45° FOV, retinal fundus photograph
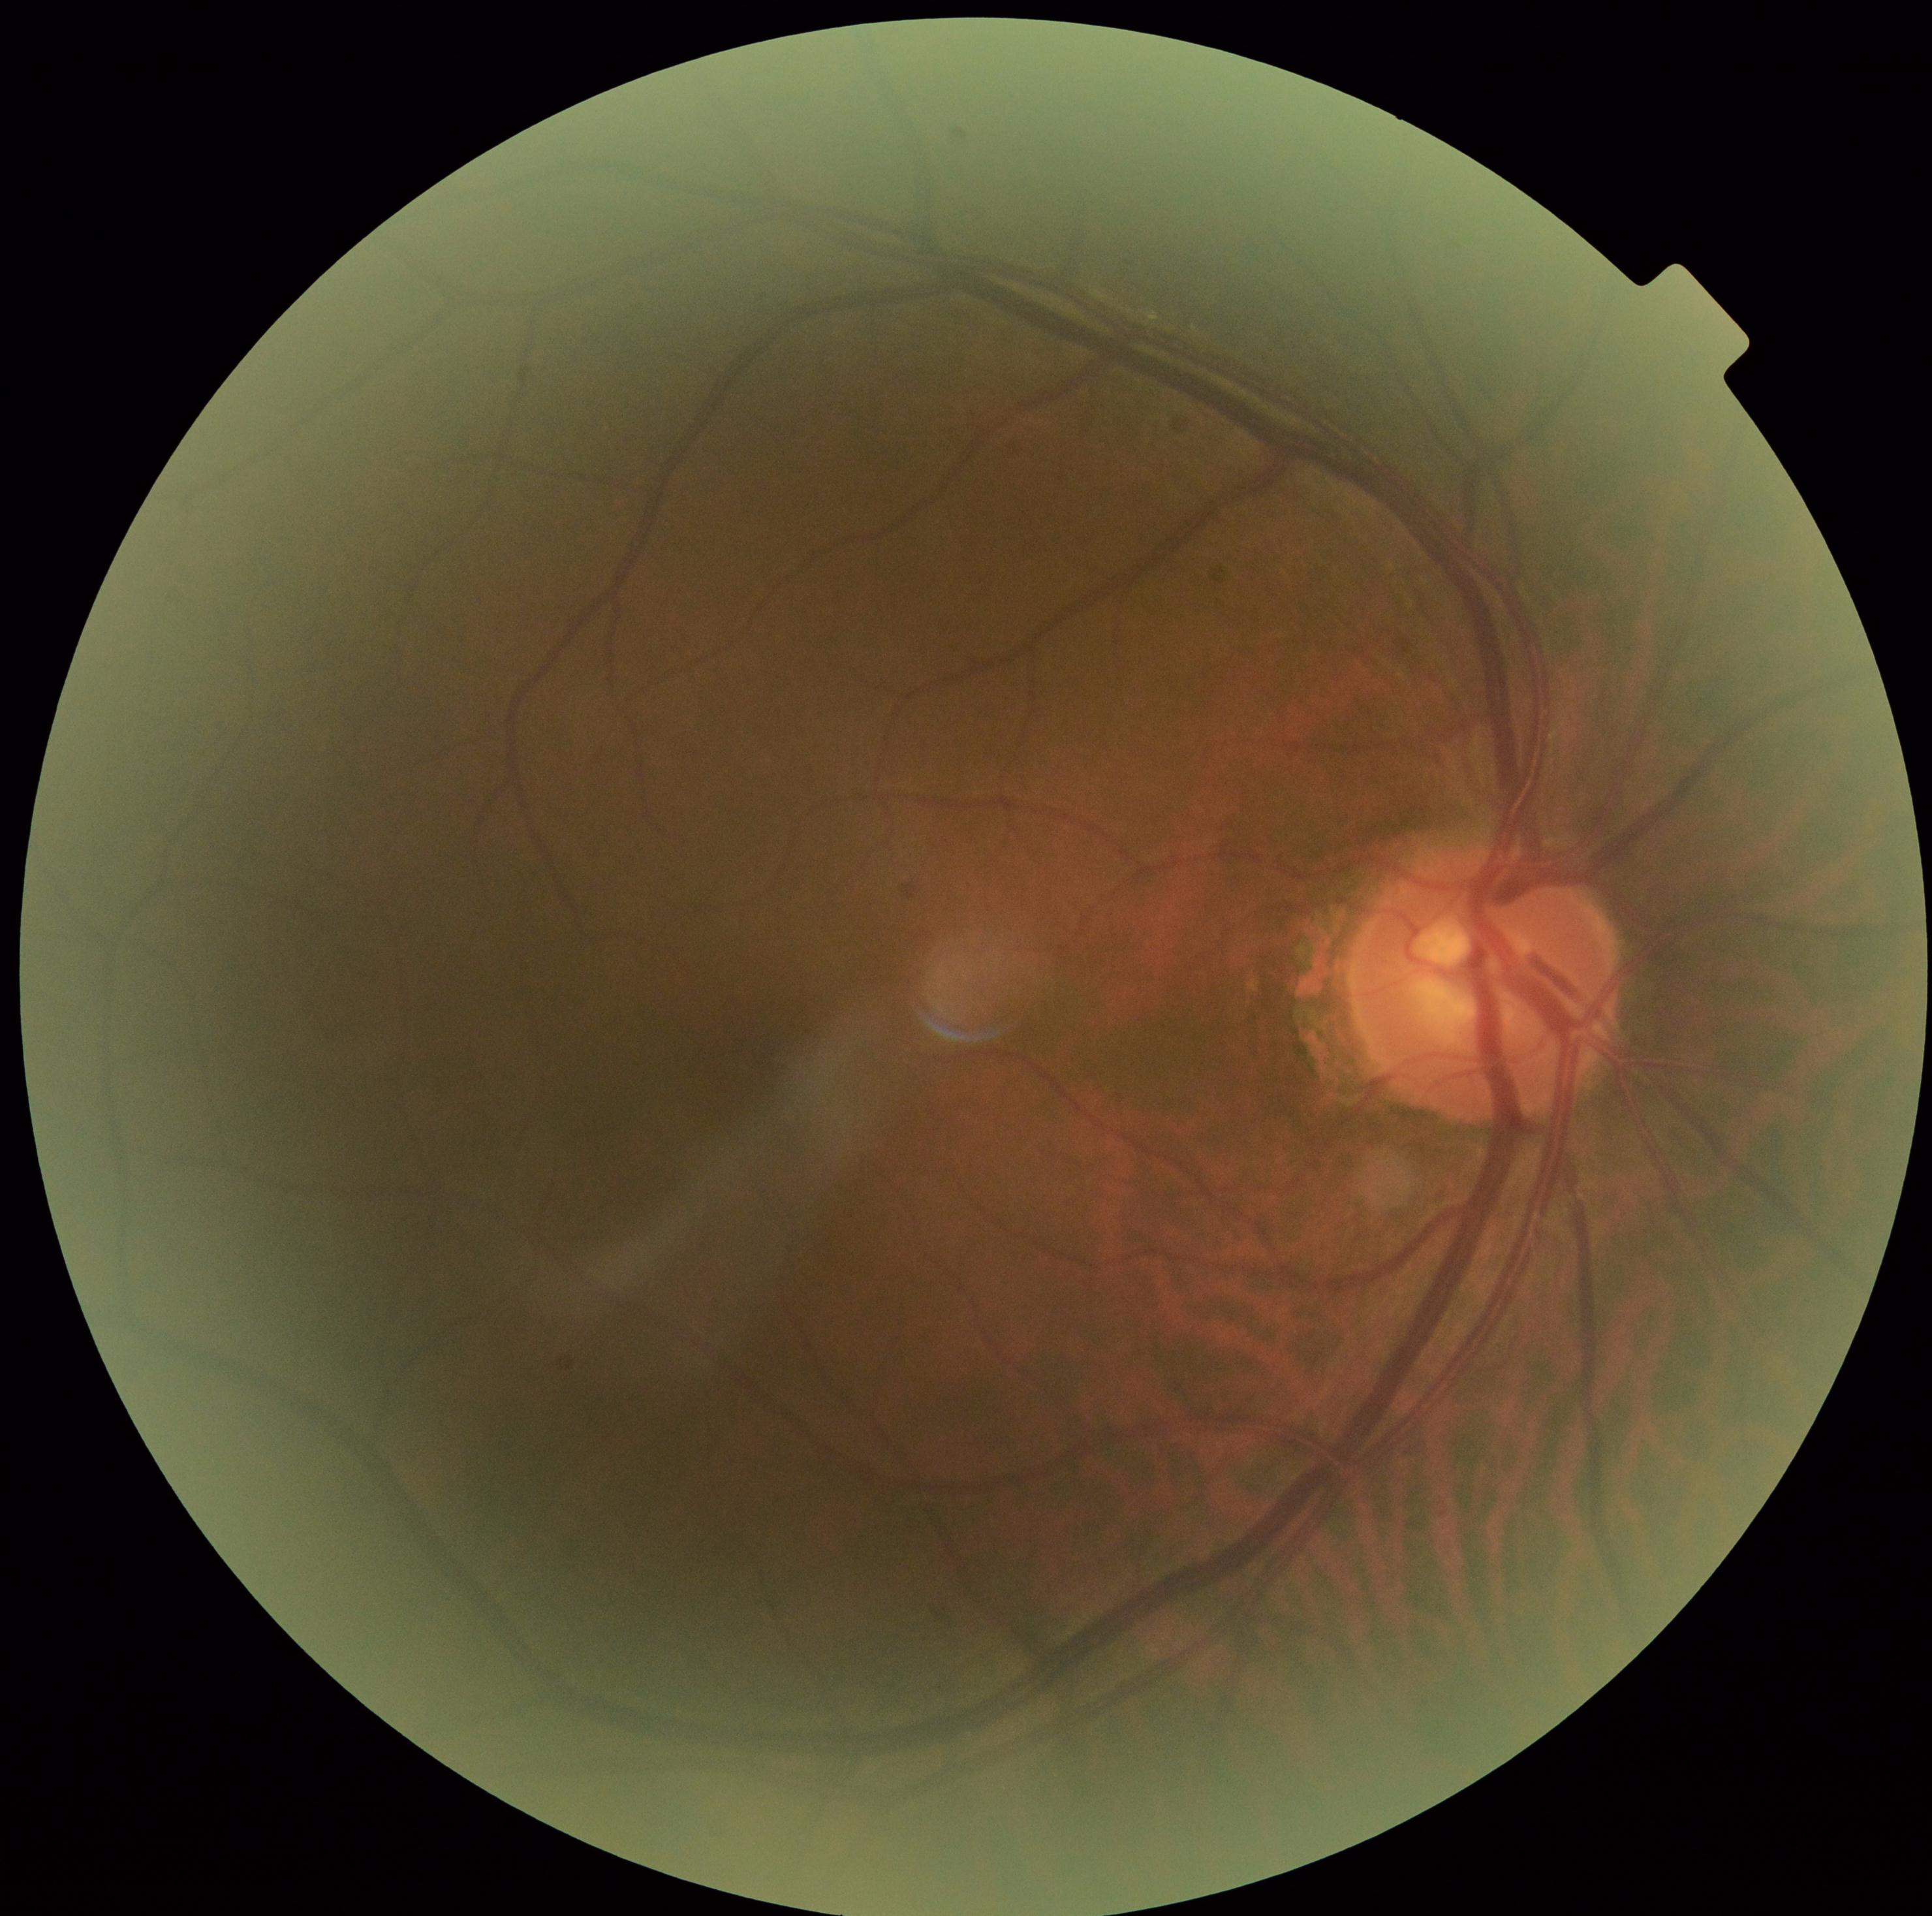 Diabetic retinopathy (DR) is no apparent diabetic retinopathy (grade 0) — no visible signs of diabetic retinopathy.